Image size 2352x1568. Fundus photo. 45-degree field of view — 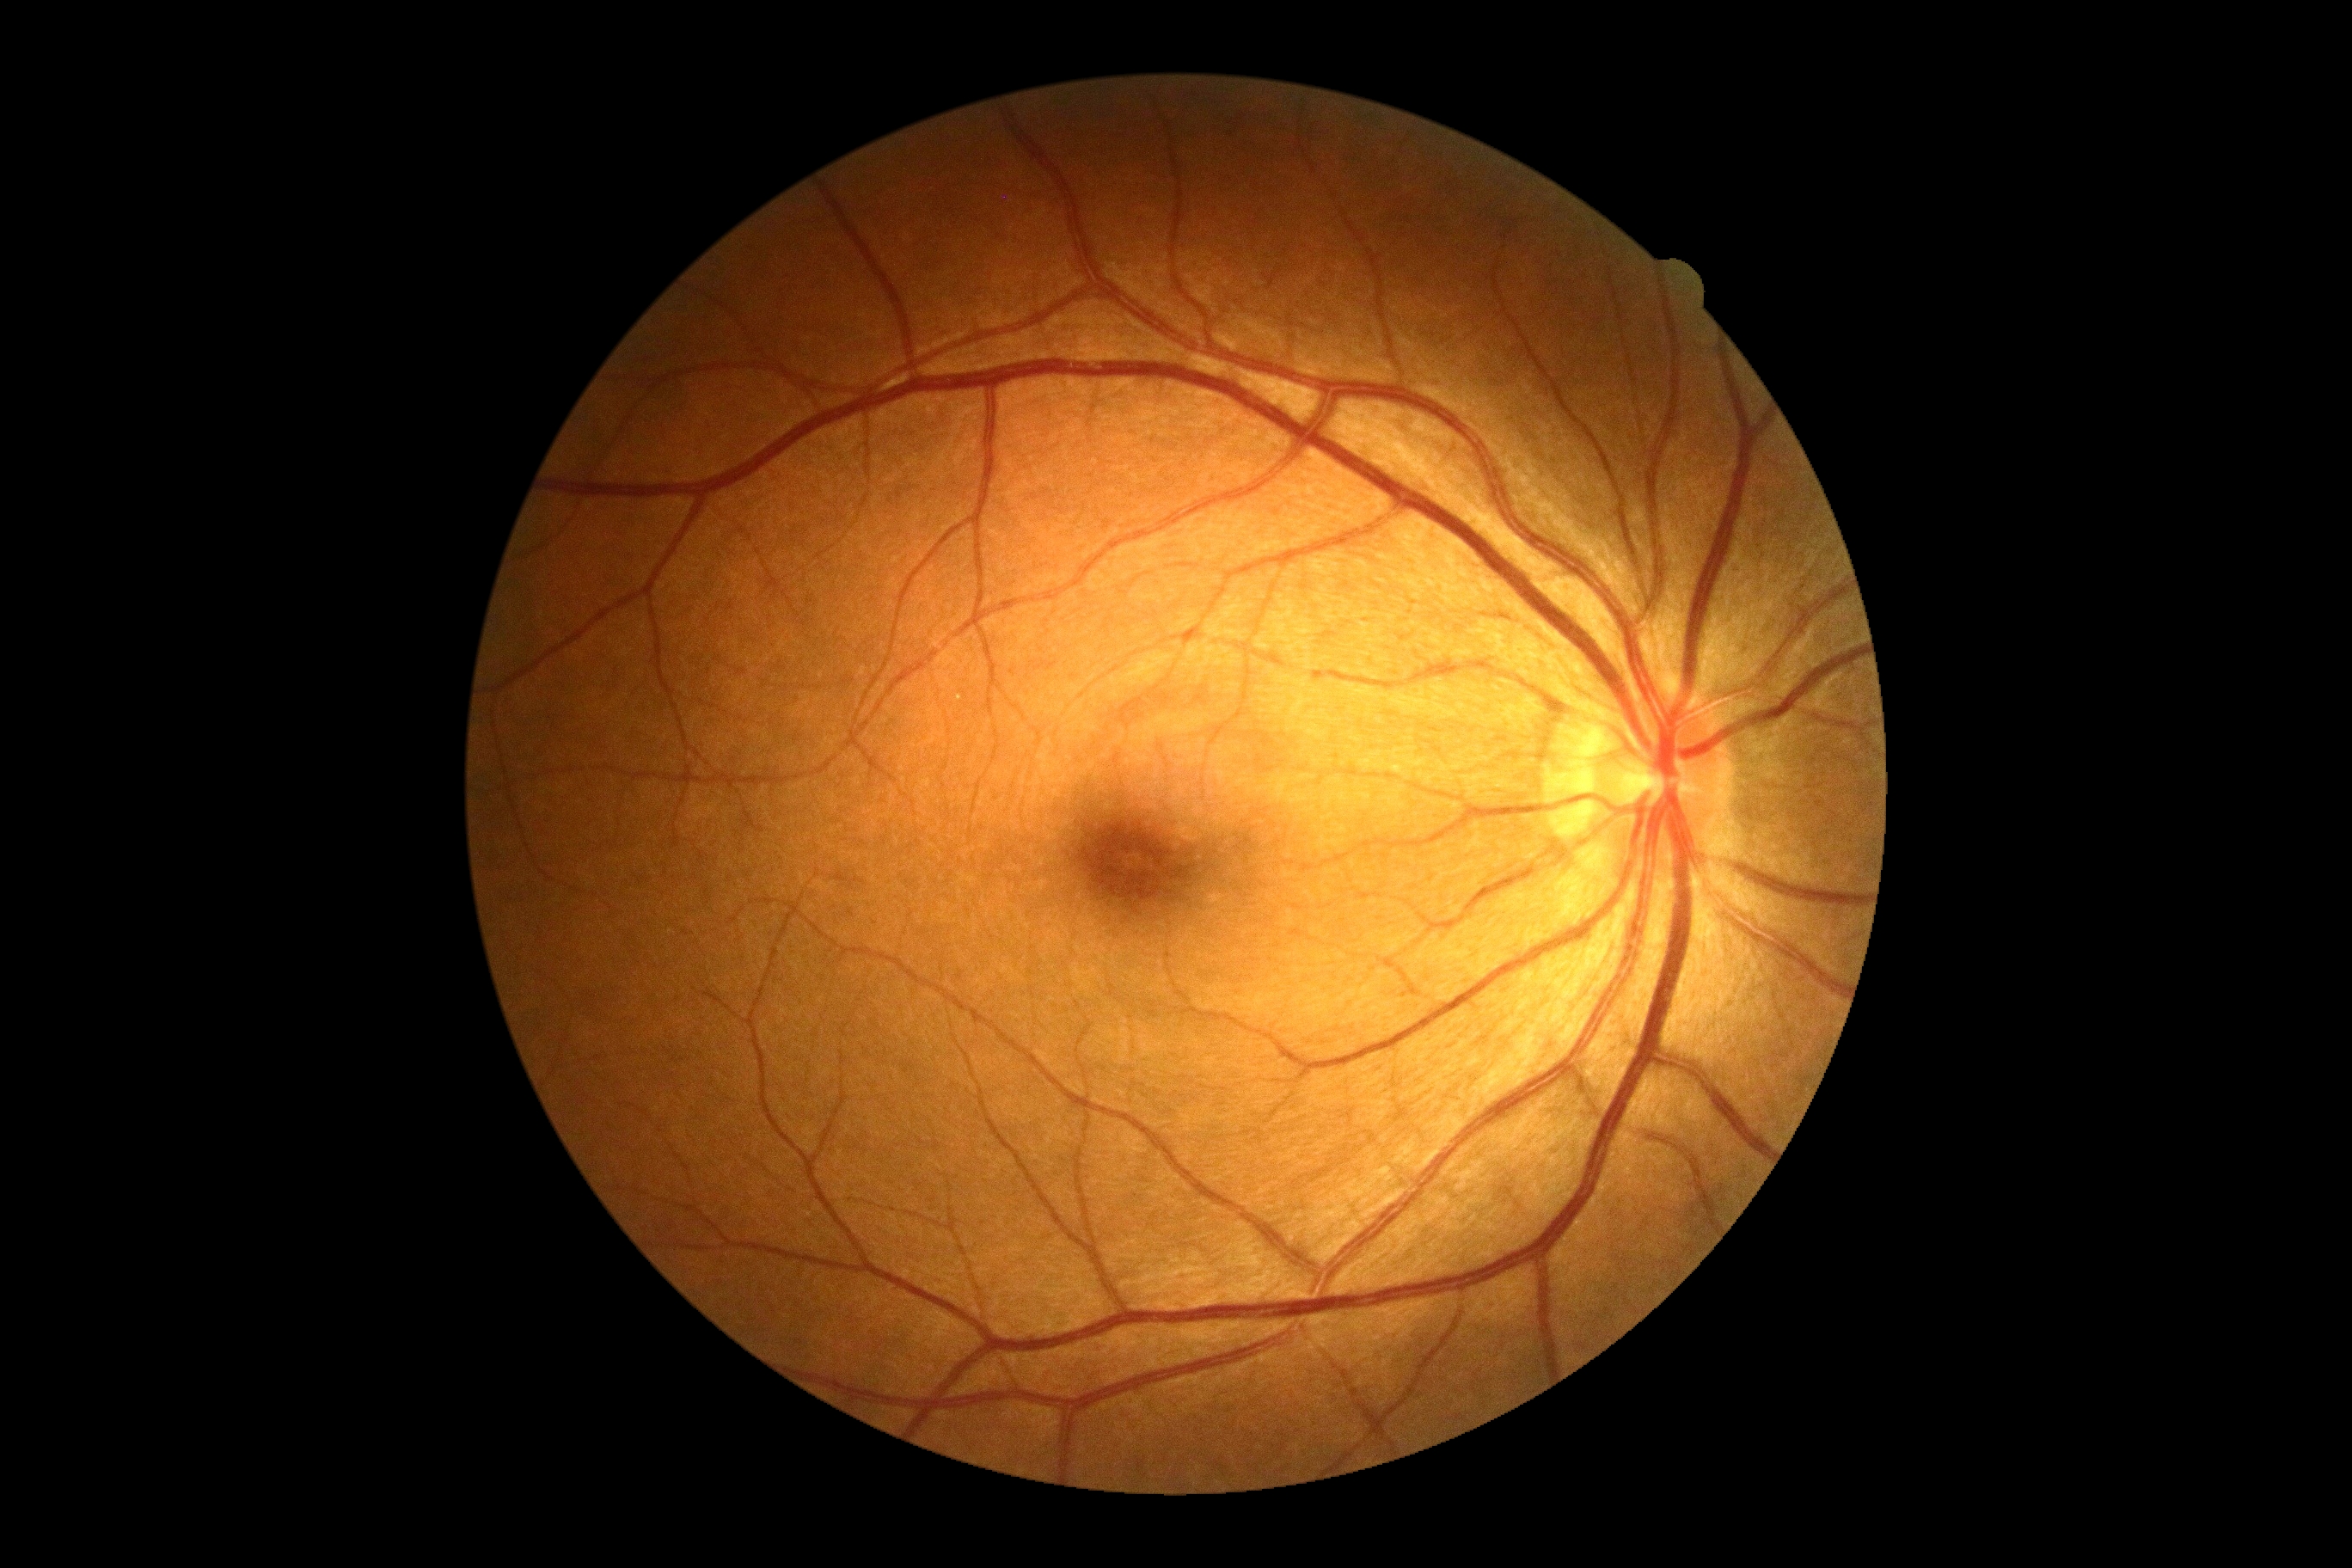 DR: grade 0 (no apparent retinopathy) — no visible signs of diabetic retinopathy.